FOV: 50 degrees · color fundus photograph · camera: Kowa VX-10α · 2361 x 1568 pixels · dilated-pupil acquisition · macula-centered.
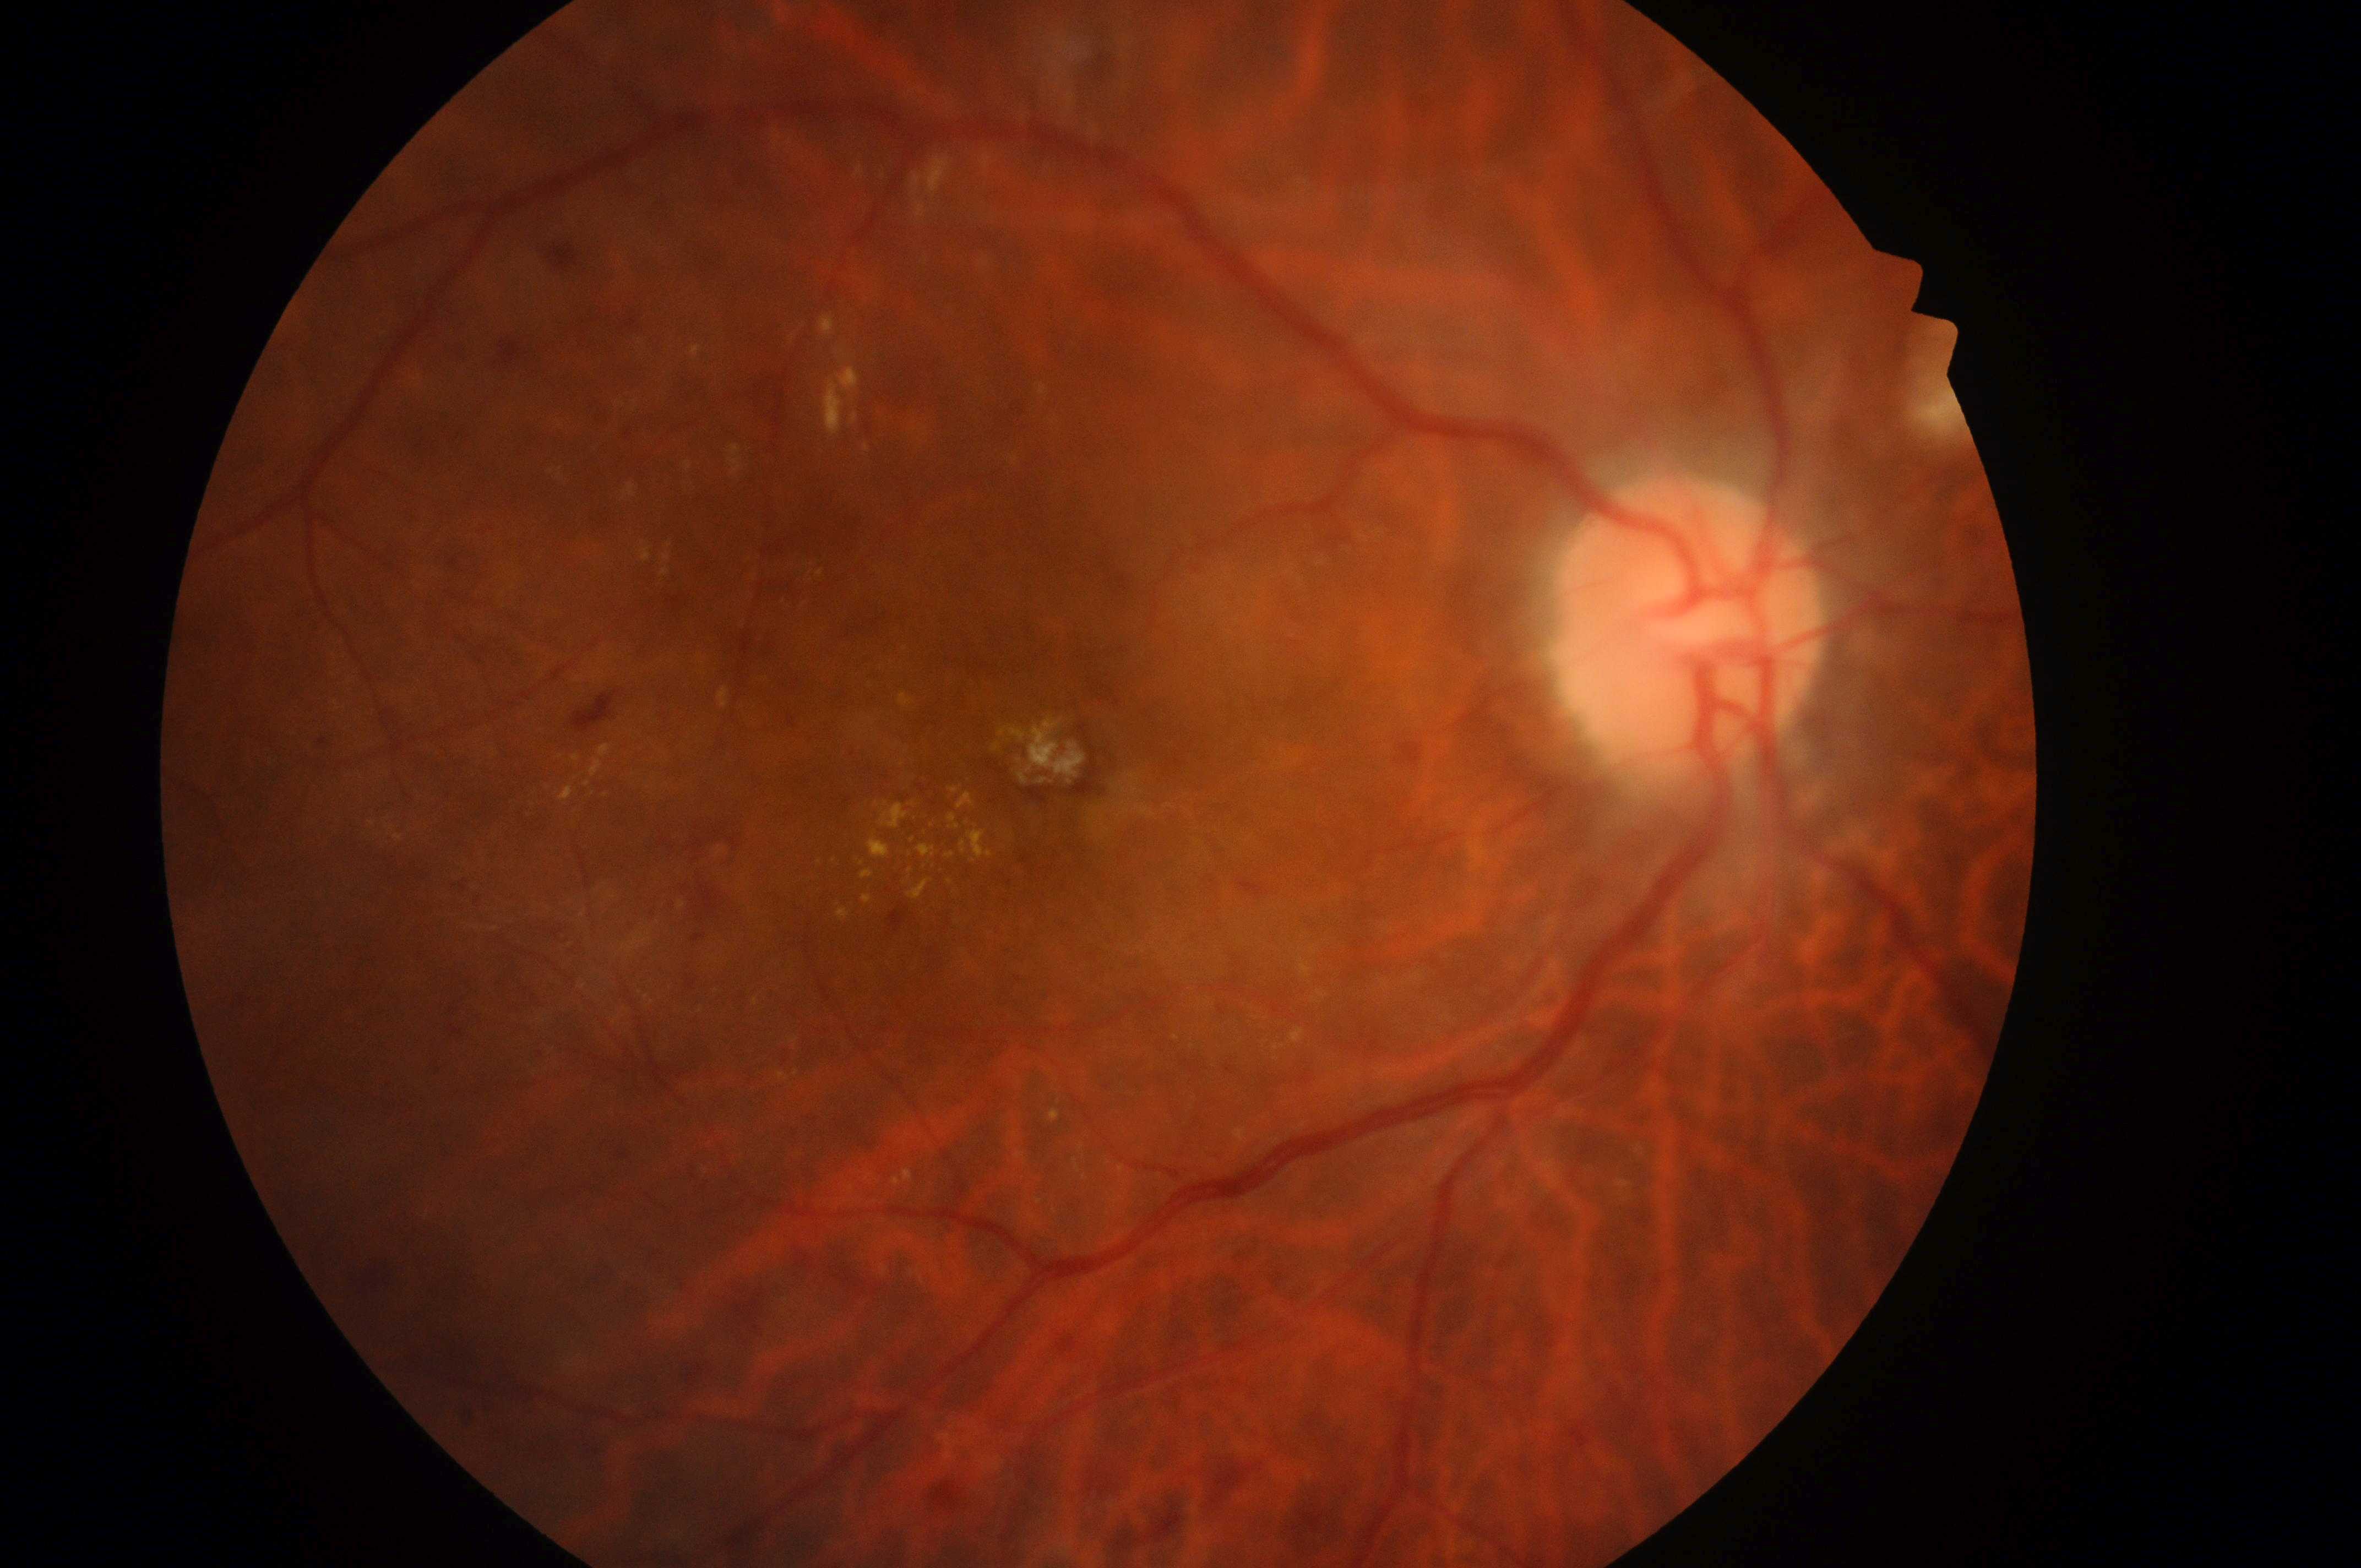
Risk of diabetic macular edema is high risk (grade 2).
Imaged eye: right.
ONH located at (1691,639).
Retinopathy grade: 3 (severe NPDR).
Macula center: (1058,769).